1924 by 1556 pixels. UWF retinal mosaic. 200° FOV — 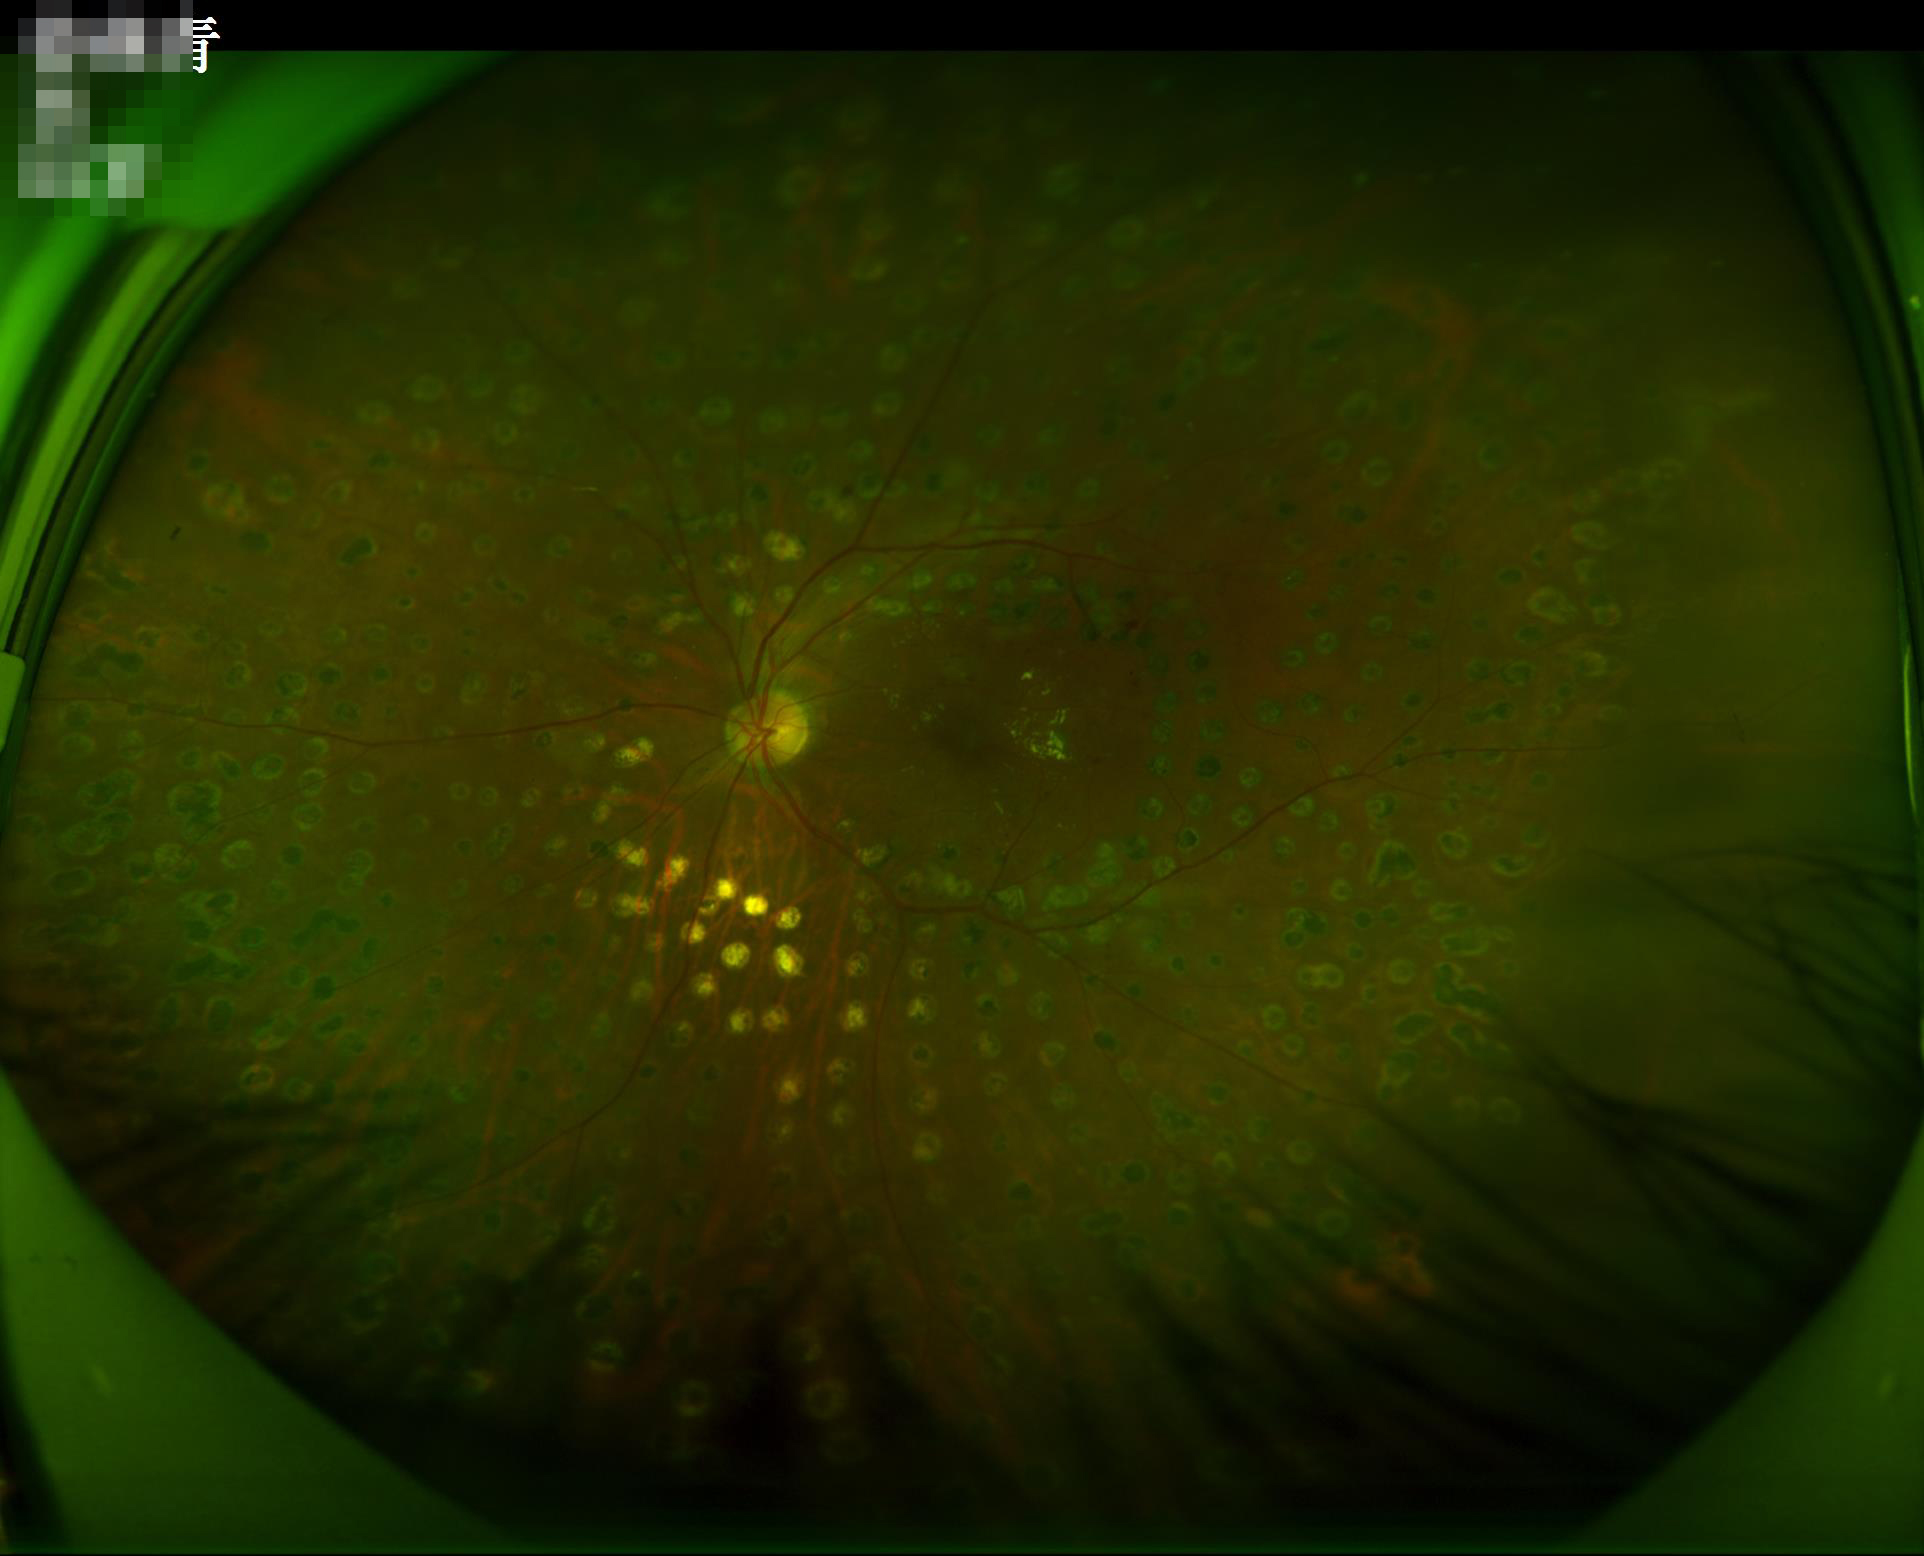 Image quality: focus: clear with no noticeable blur | illumination/color: uneven illumination or color cast | overall: good and suitable for diagnostic use.